69 years old · refractive error: sphere +1.5 D, cylinder -0.5 D, axis 100° · man patient · axial length 23.62 mm · IOP (pneumatic tonometry): 20 mmHg · pachymetry 568 µm.
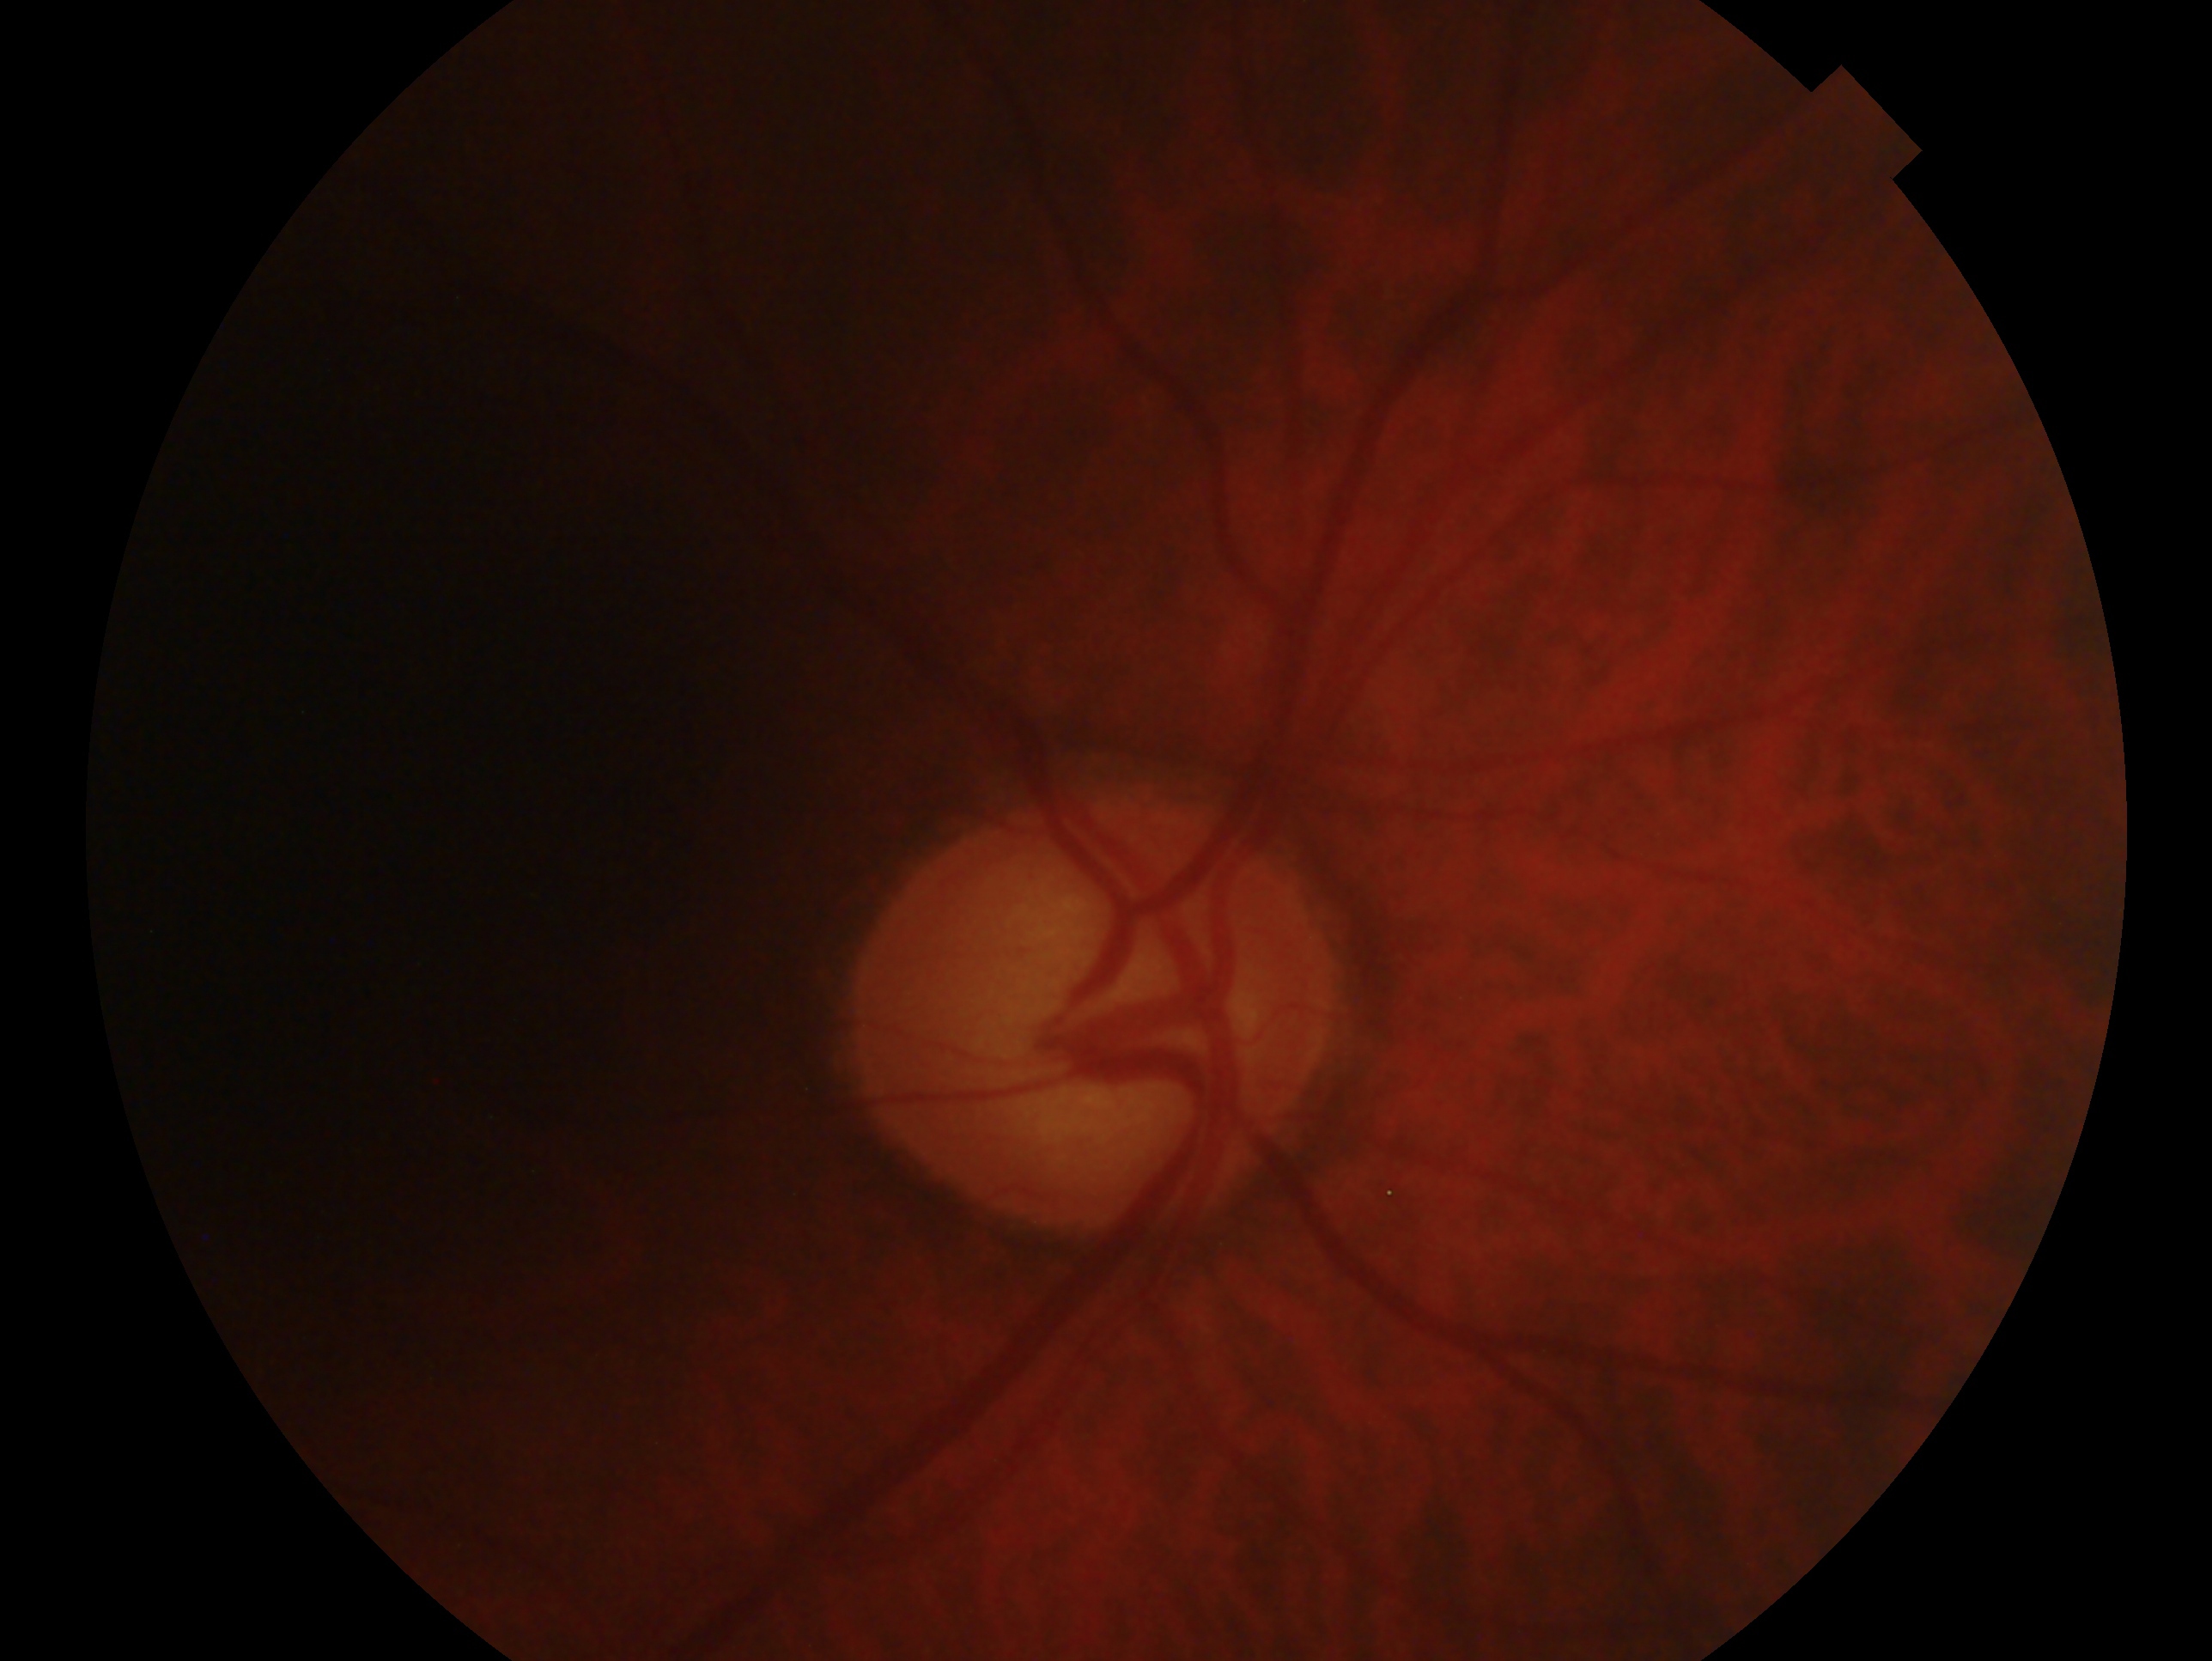

glaucoma status: glaucoma, eye: OD.